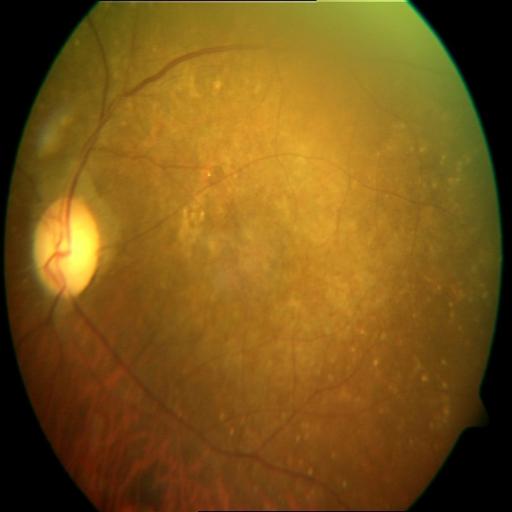
Diagnoses (2): chorioretinitis (CRS), optic disc cupping (ODC).